Modified Davis grading · NIDEK AFC-230 fundus camera
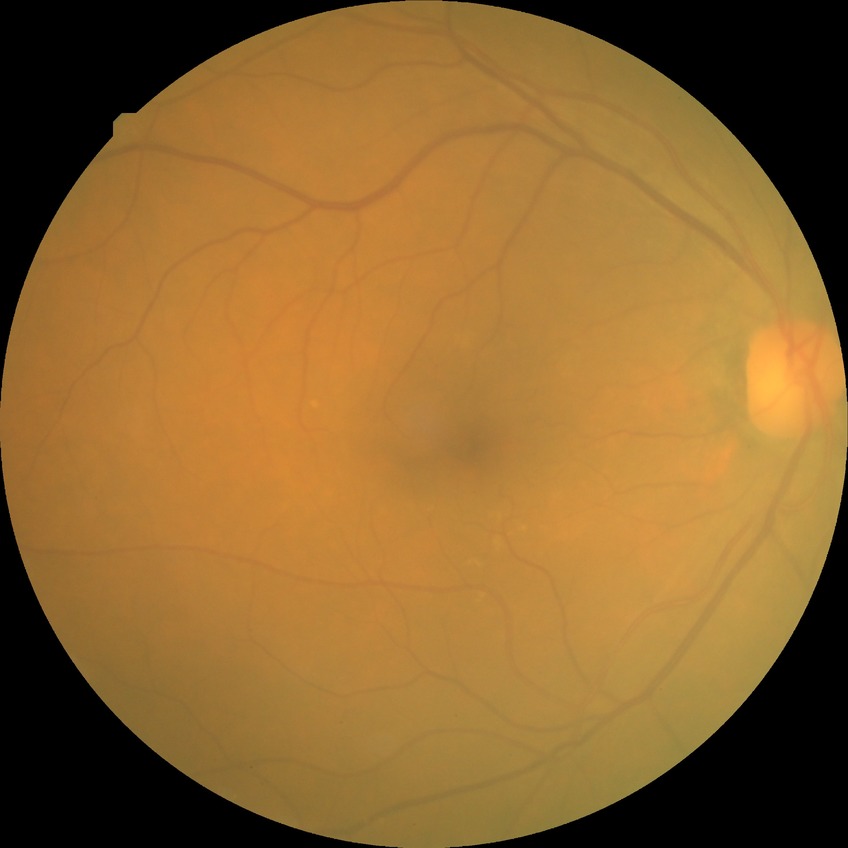 davis_grade: NDR